Image size 1932x1932 · CFP · 45-degree field of view.
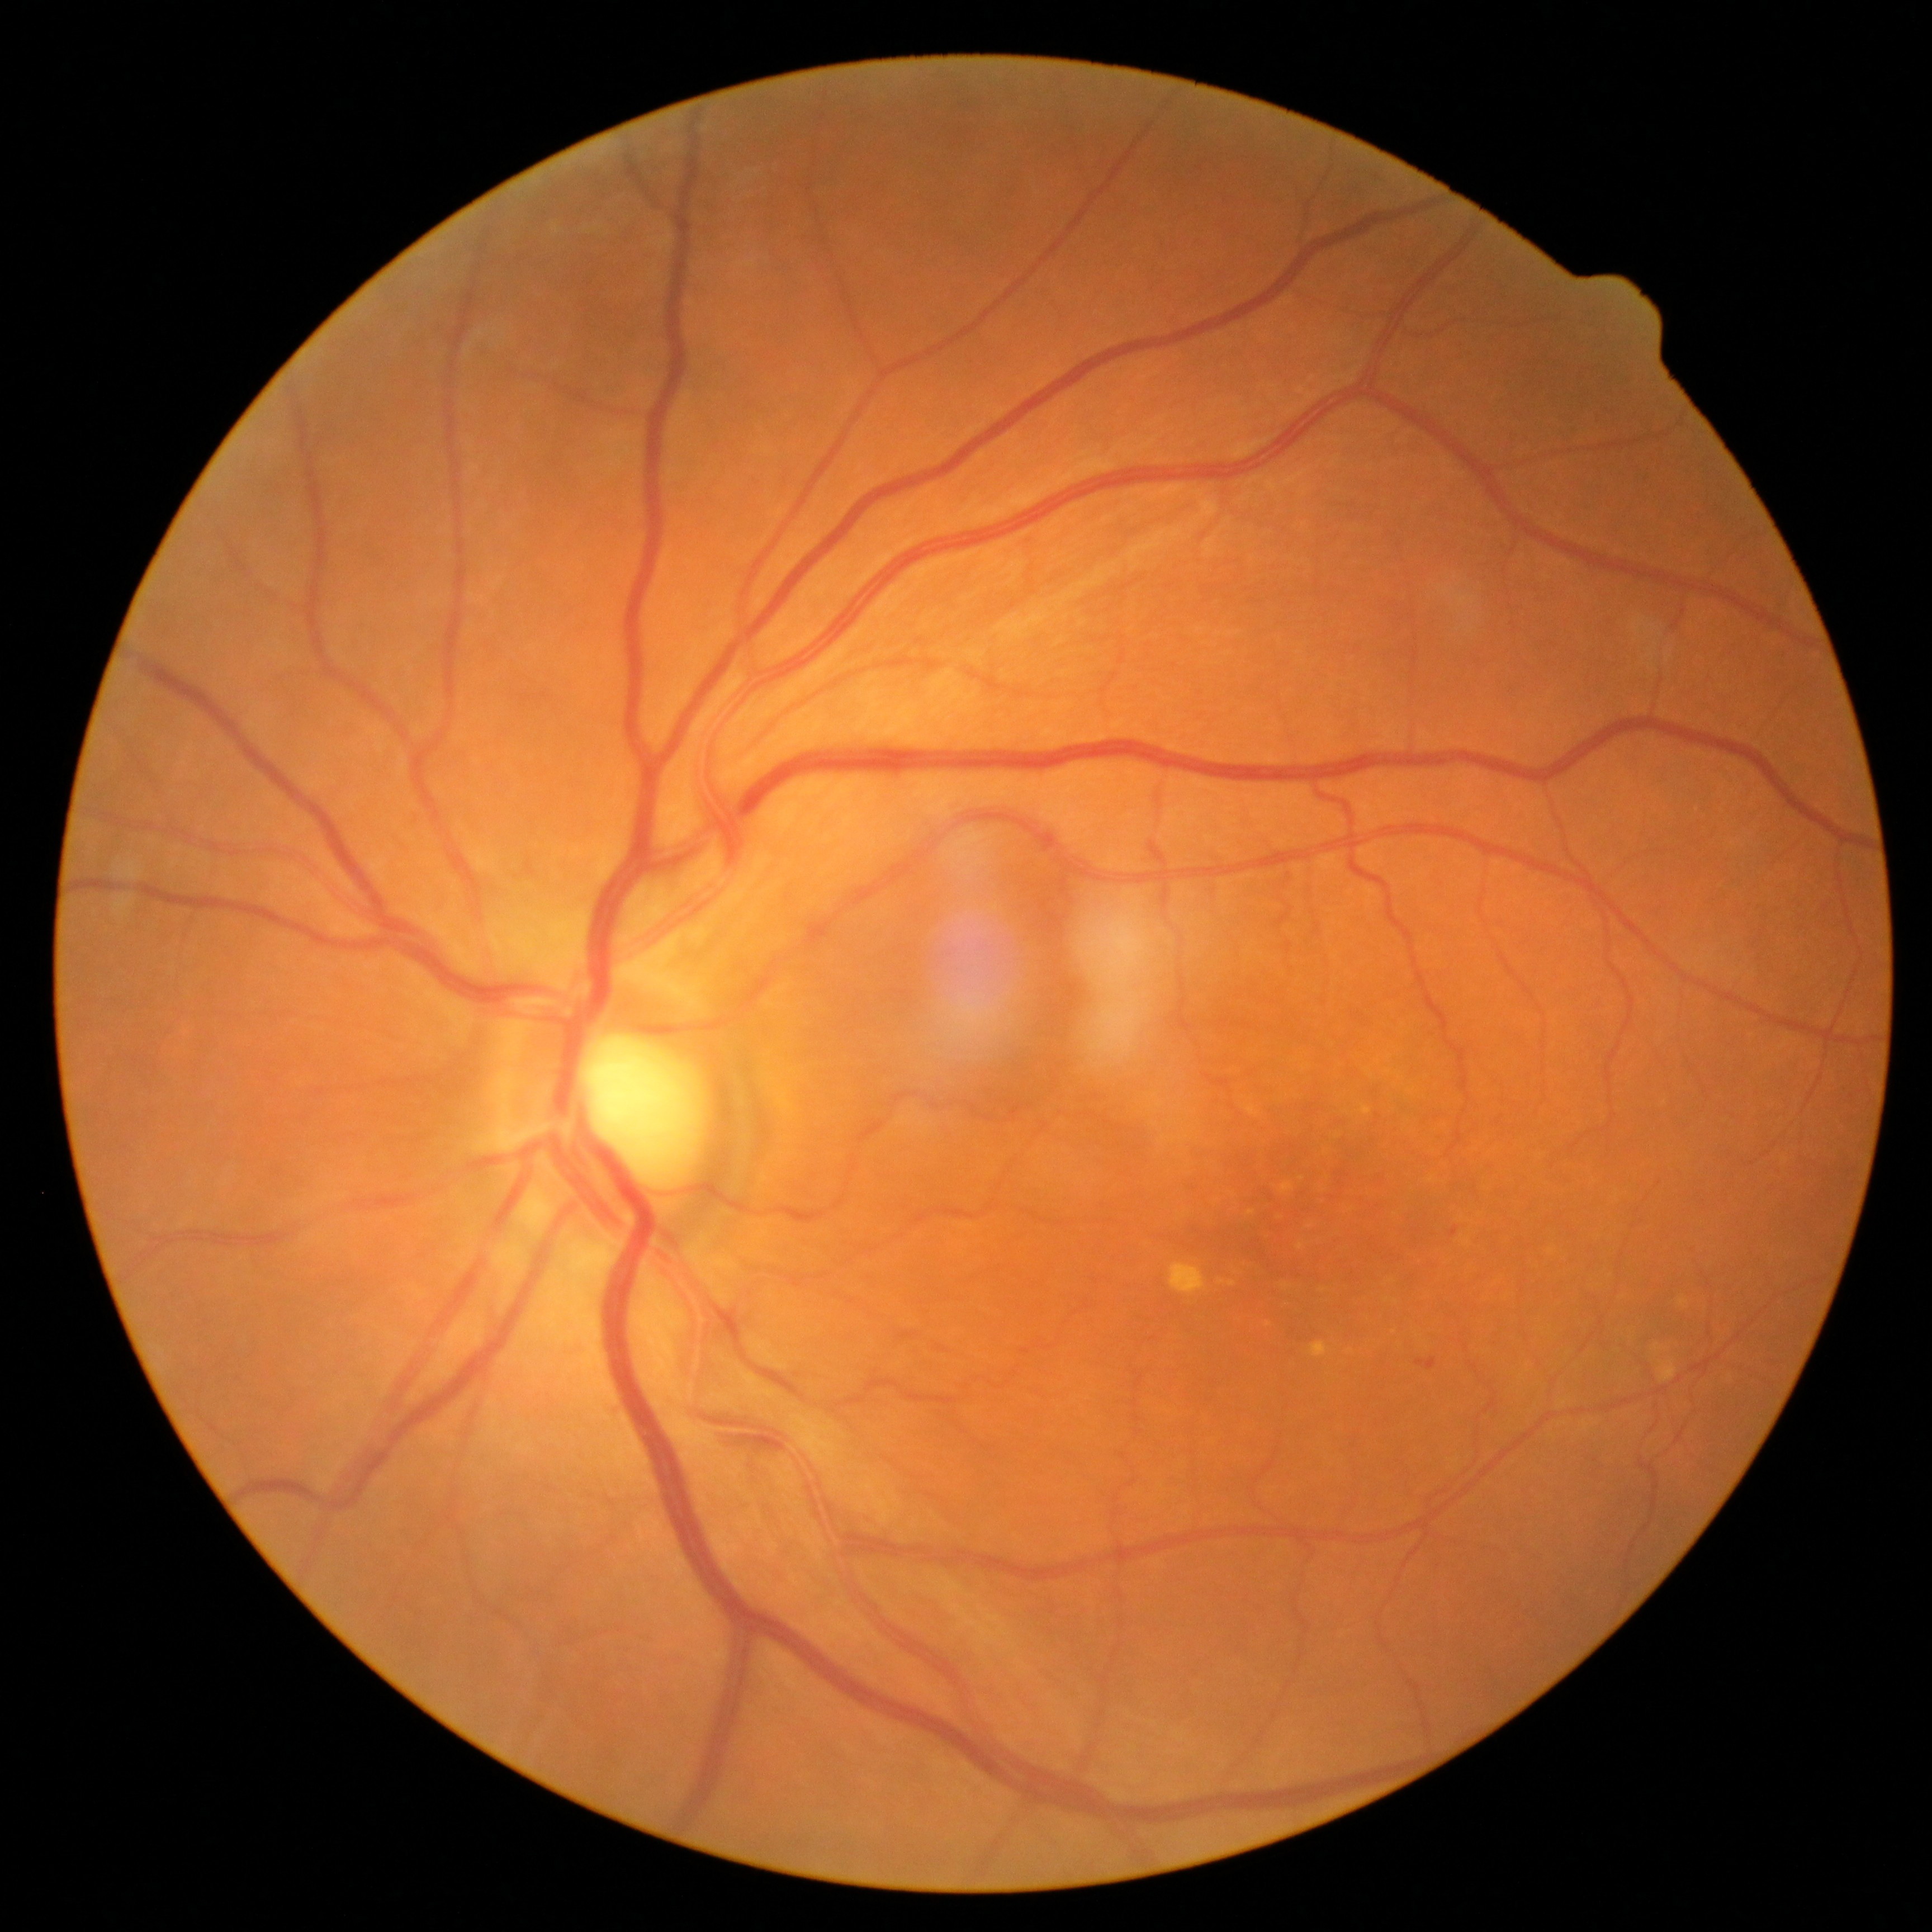 Findings:
- DR class: non-proliferative diabetic retinopathy
- DR grade: 1